Wide-field fundus image from infant ROP screening
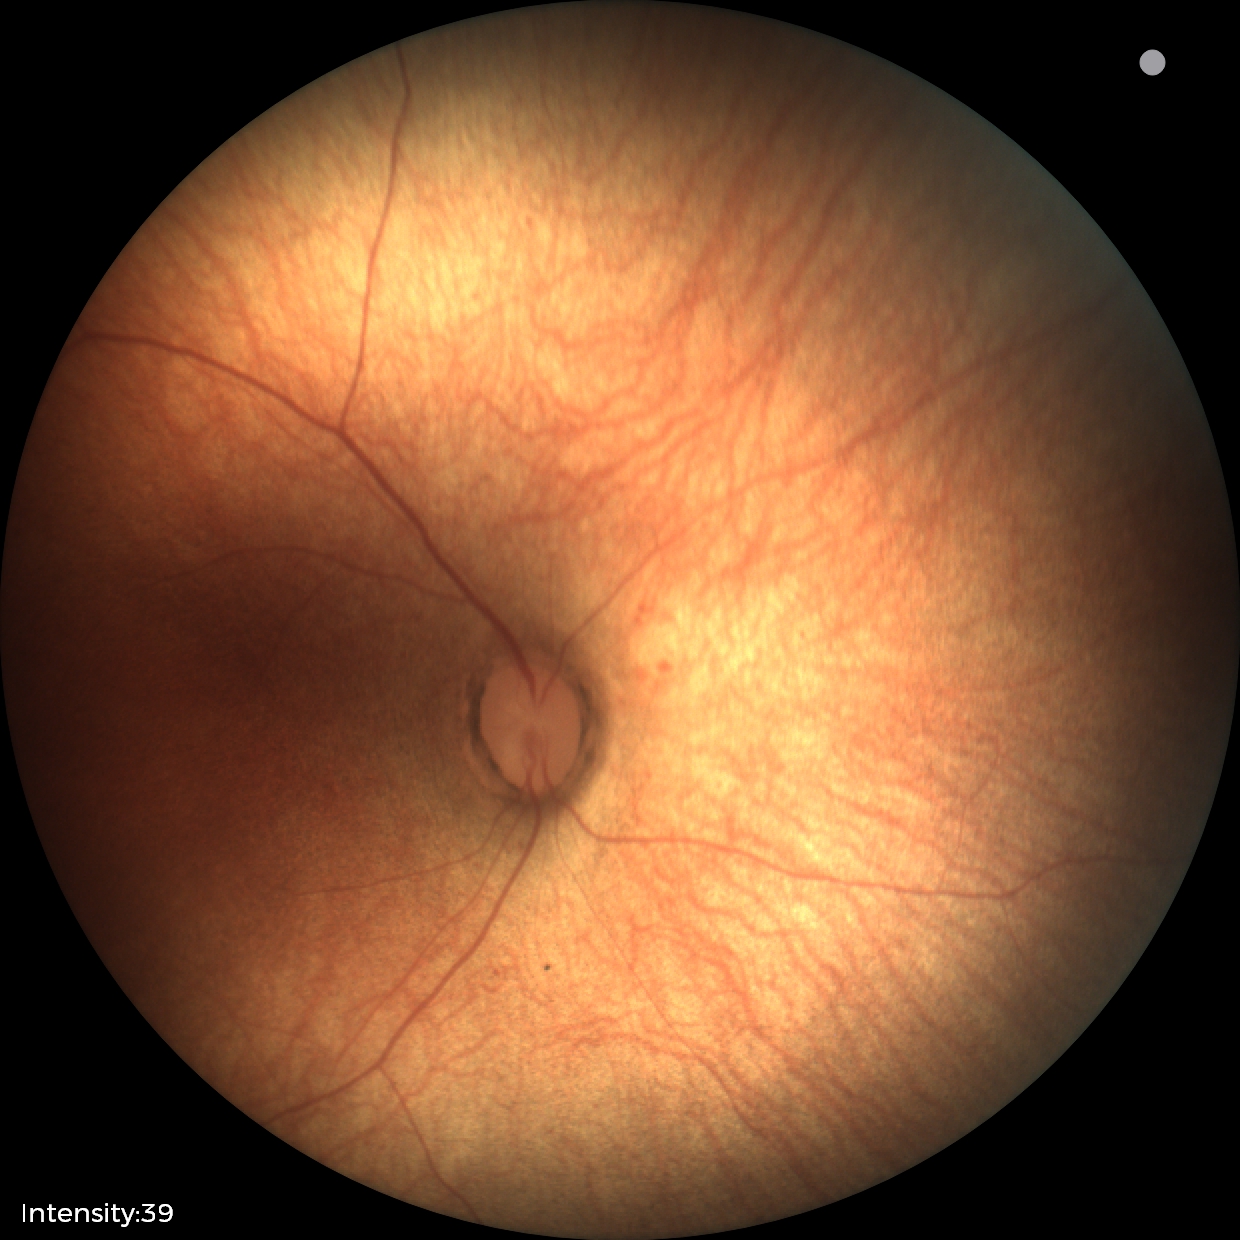

Normal screening examination.